2352 by 1568 pixels; 45° FOV: 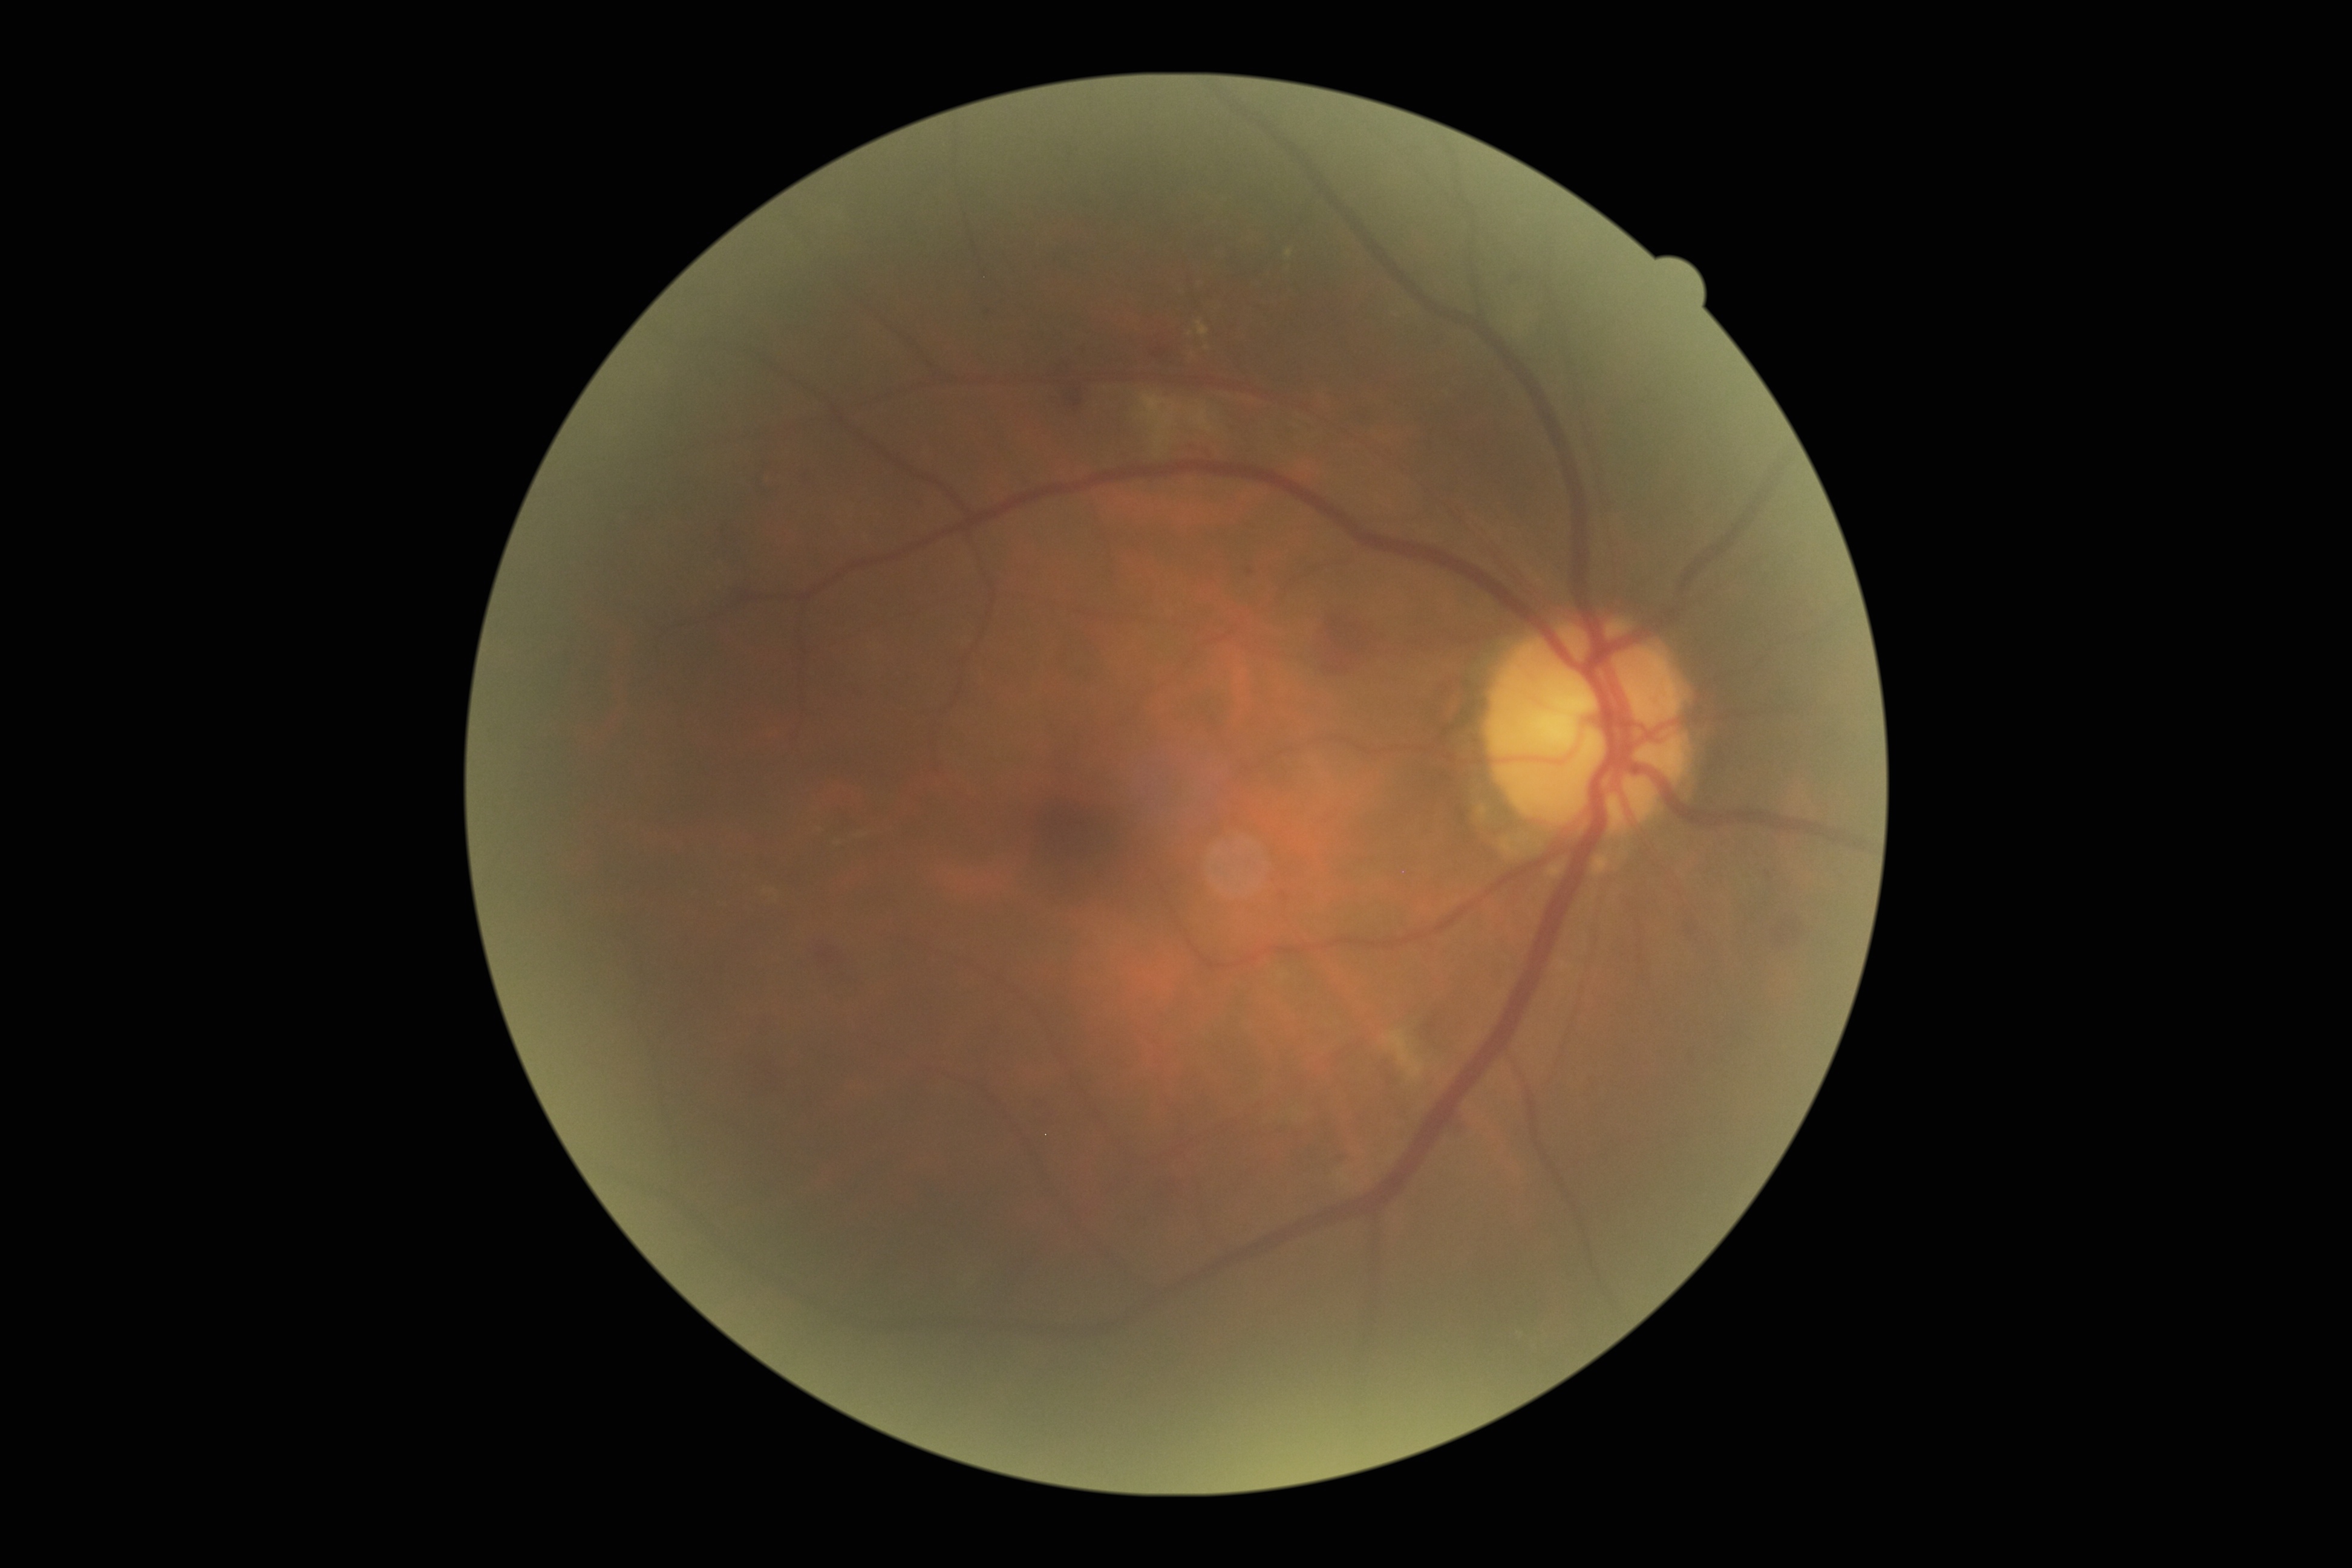

DR stage is moderate non-proliferative diabetic retinopathy (grade 2).